Image size 1725x1721:
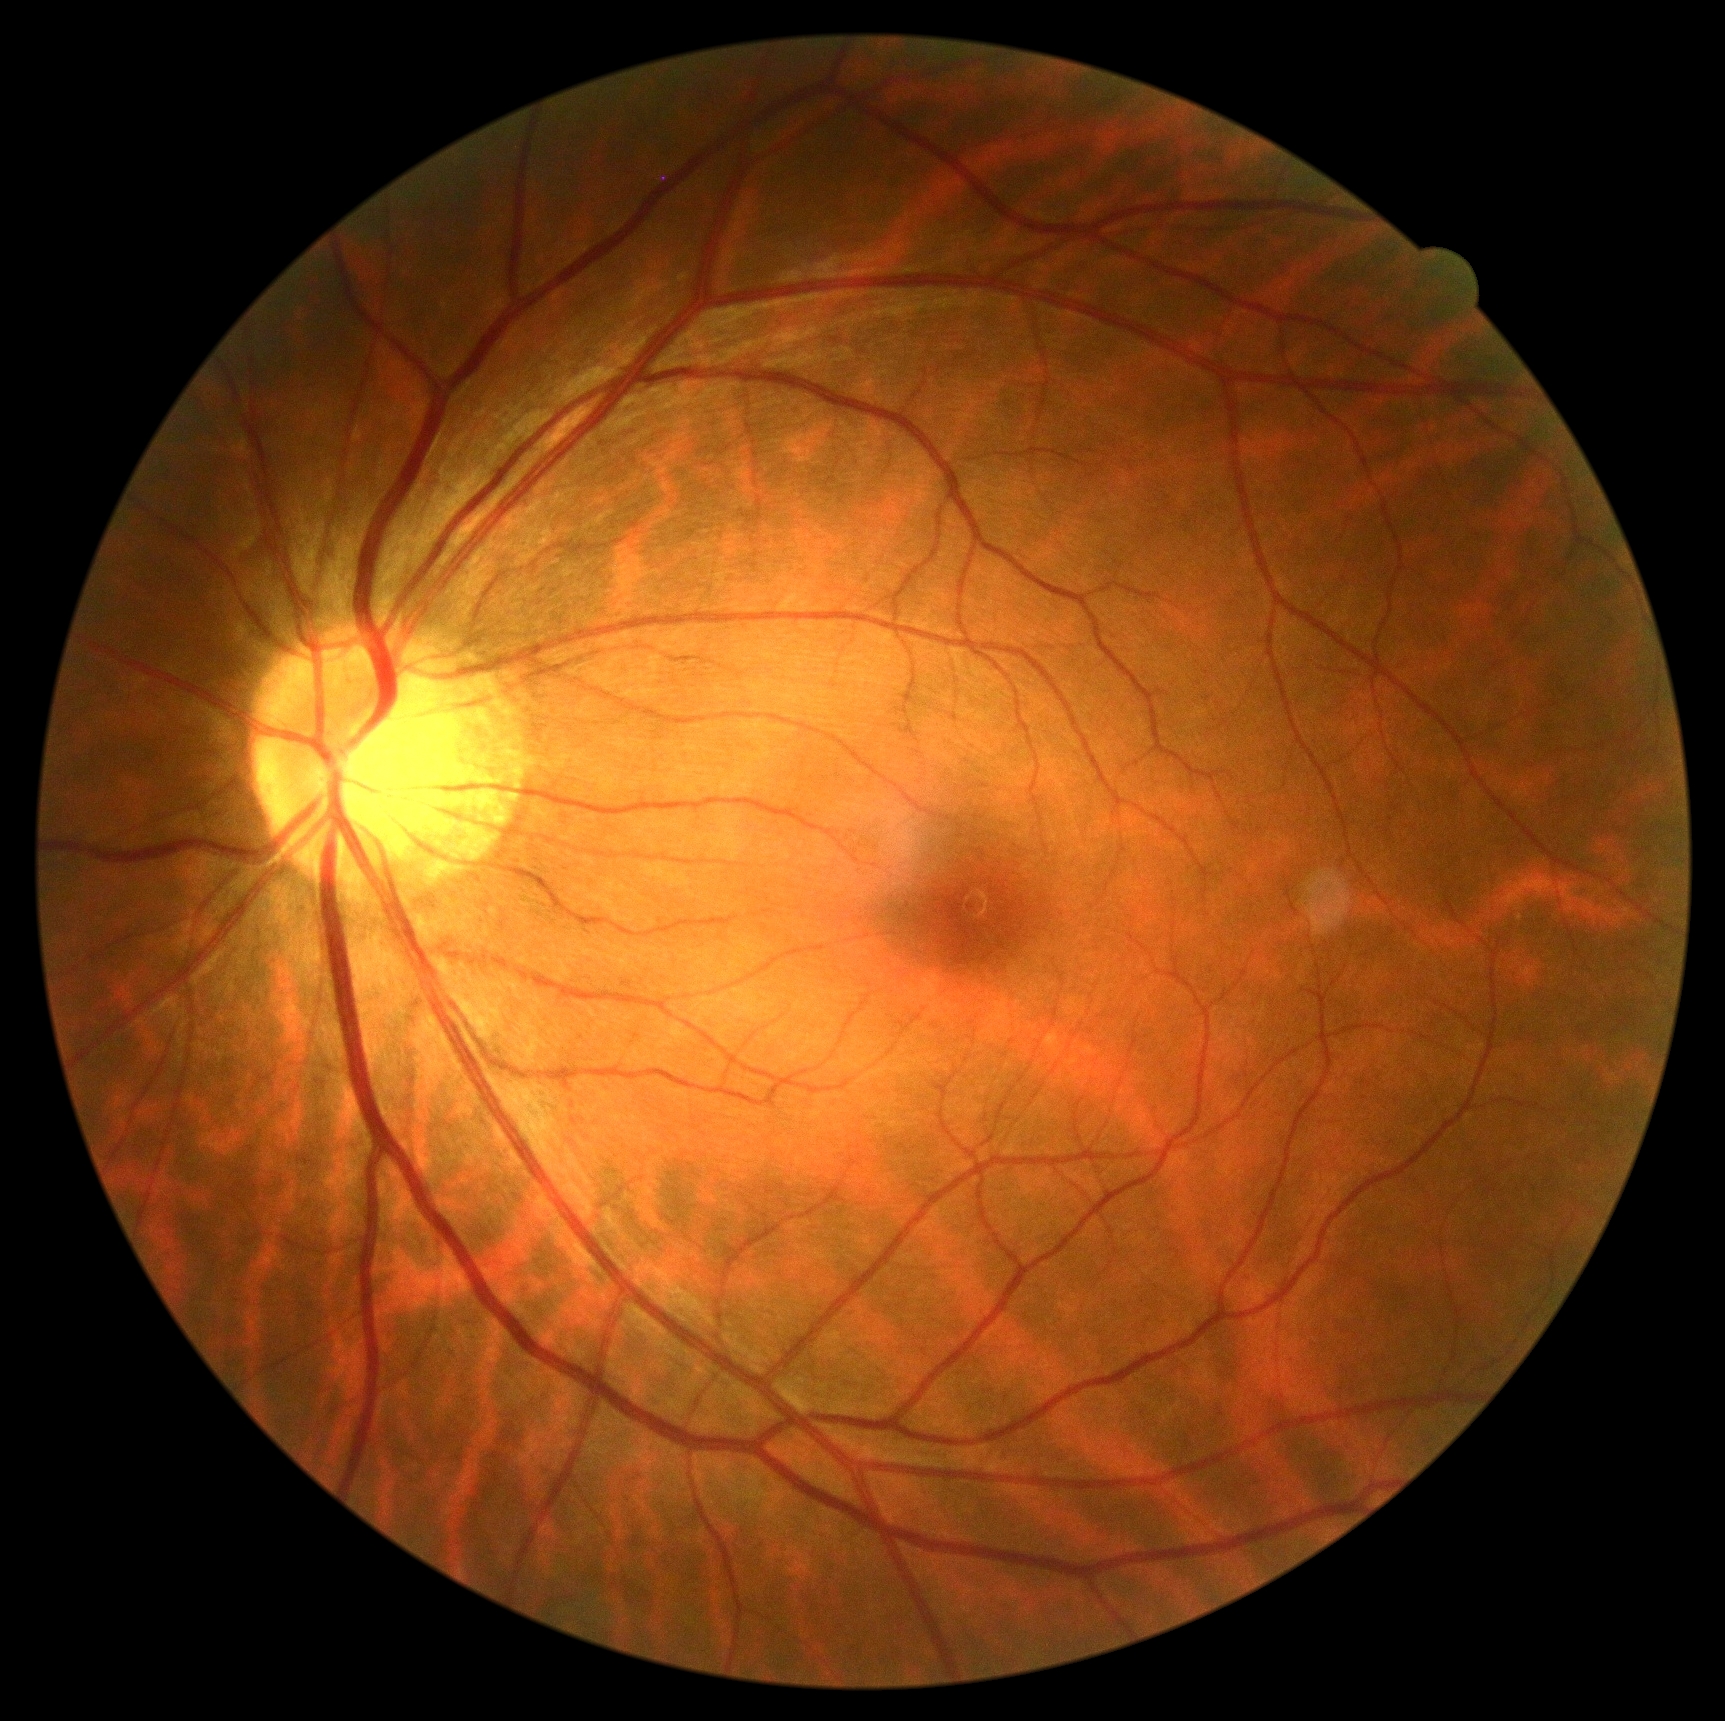

retinopathy grade@no apparent diabetic retinopathy (0).